848 x 848 pixels.
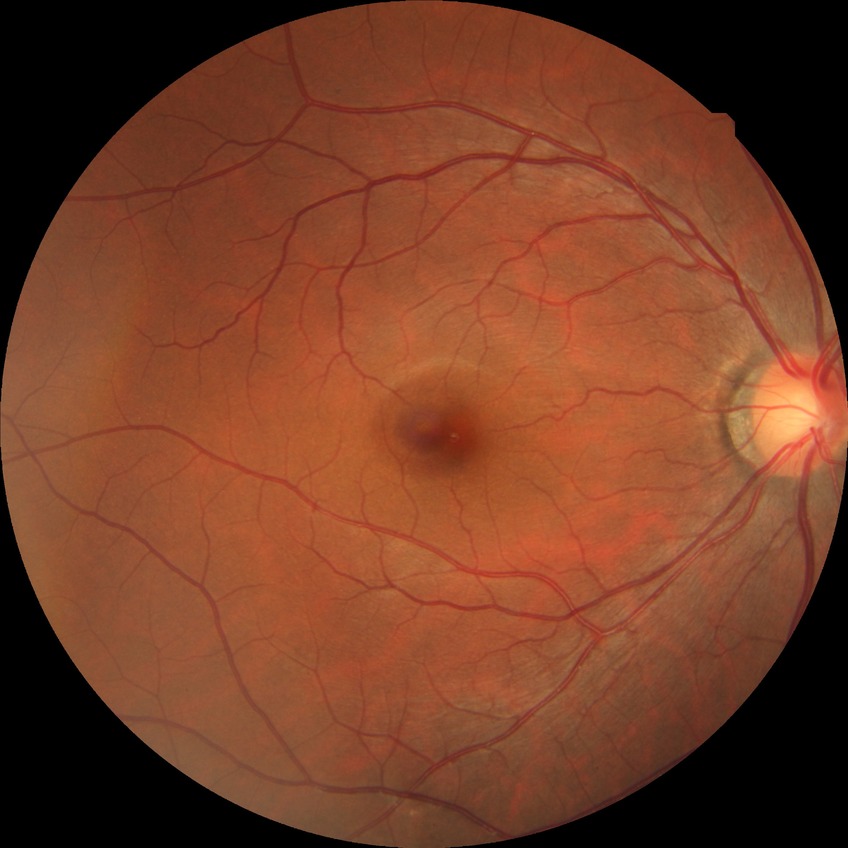   davis_grade: no diabetic retinopathy